Pediatric retinal photograph (wide-field). 640 by 480 pixels:
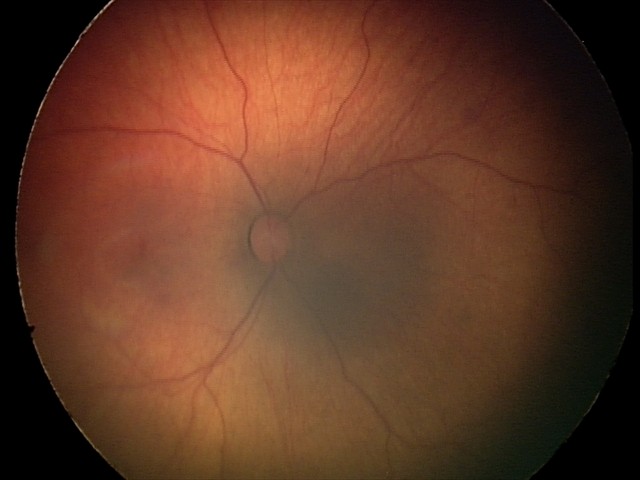

Diagnosis from this screening exam: retinal hemorrhages.